1659 by 2212 pixels. Acquired with a Remidio smartphone fundus camera:
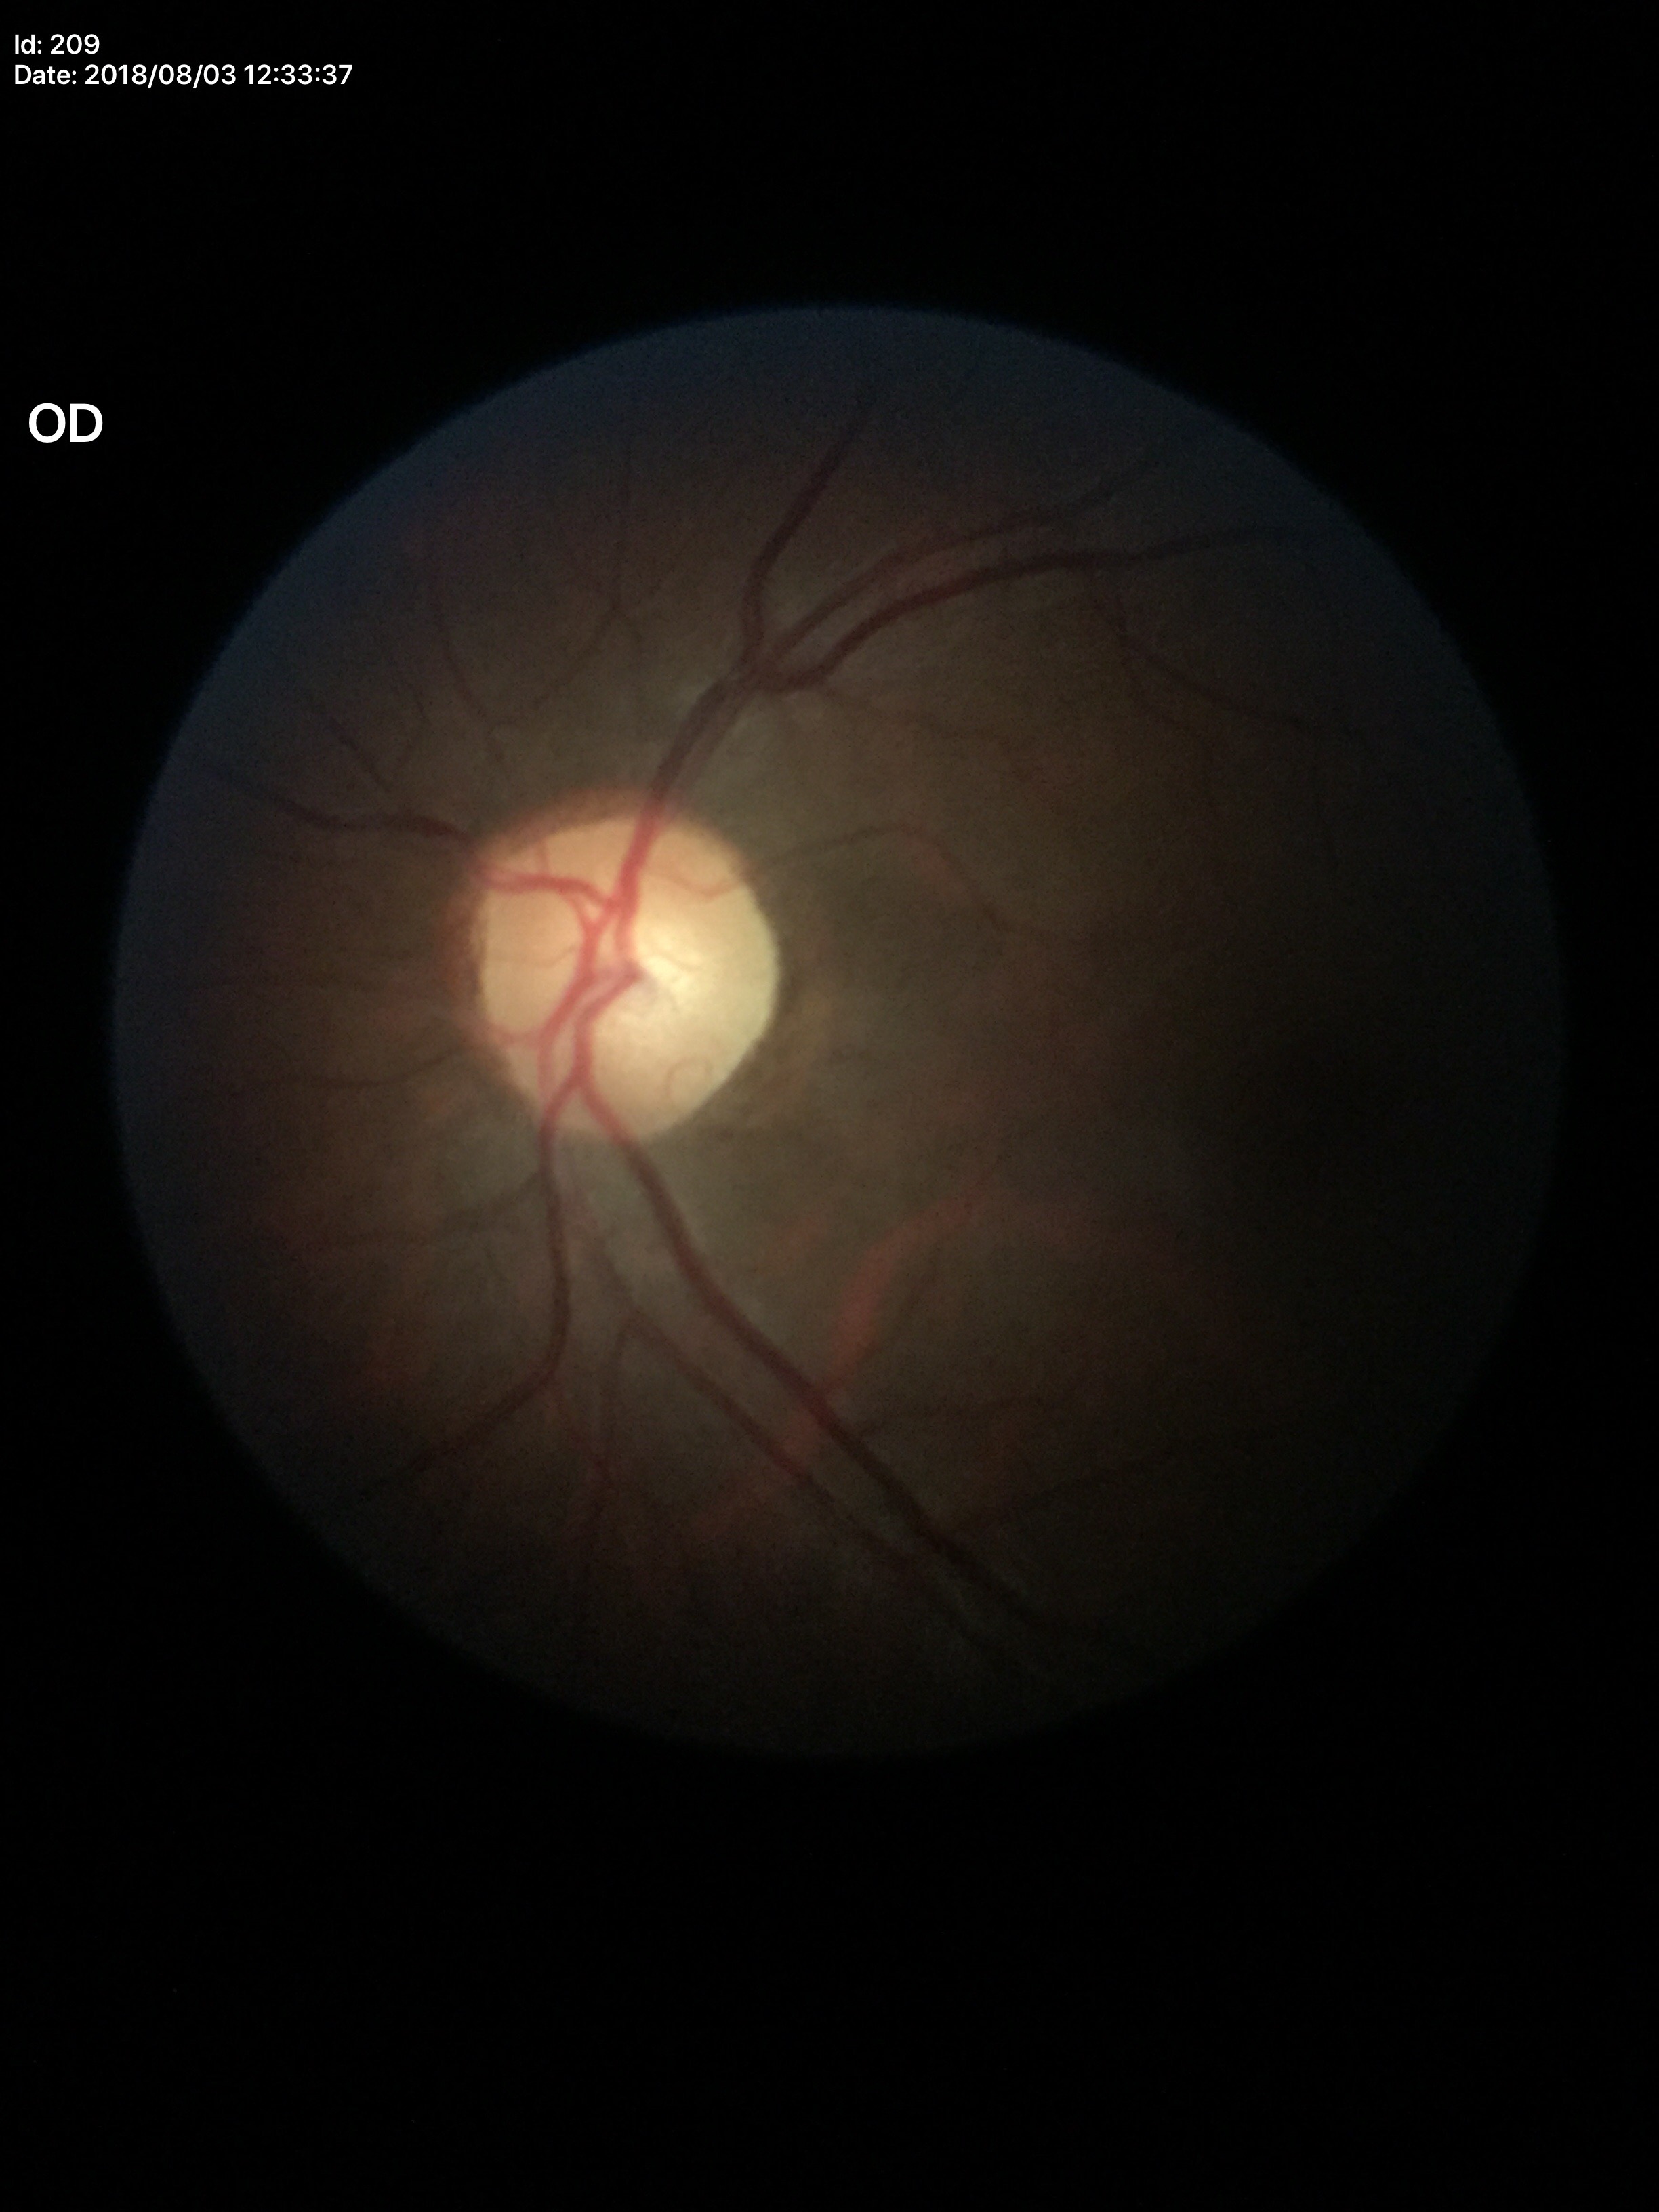

No glaucomatous optic neuropathy. Horizontal CDR (HCDR): 0.52. Vertical cup-disc ratio (VCDR) is 0.53.